Fundus photo, 45-degree field of view: 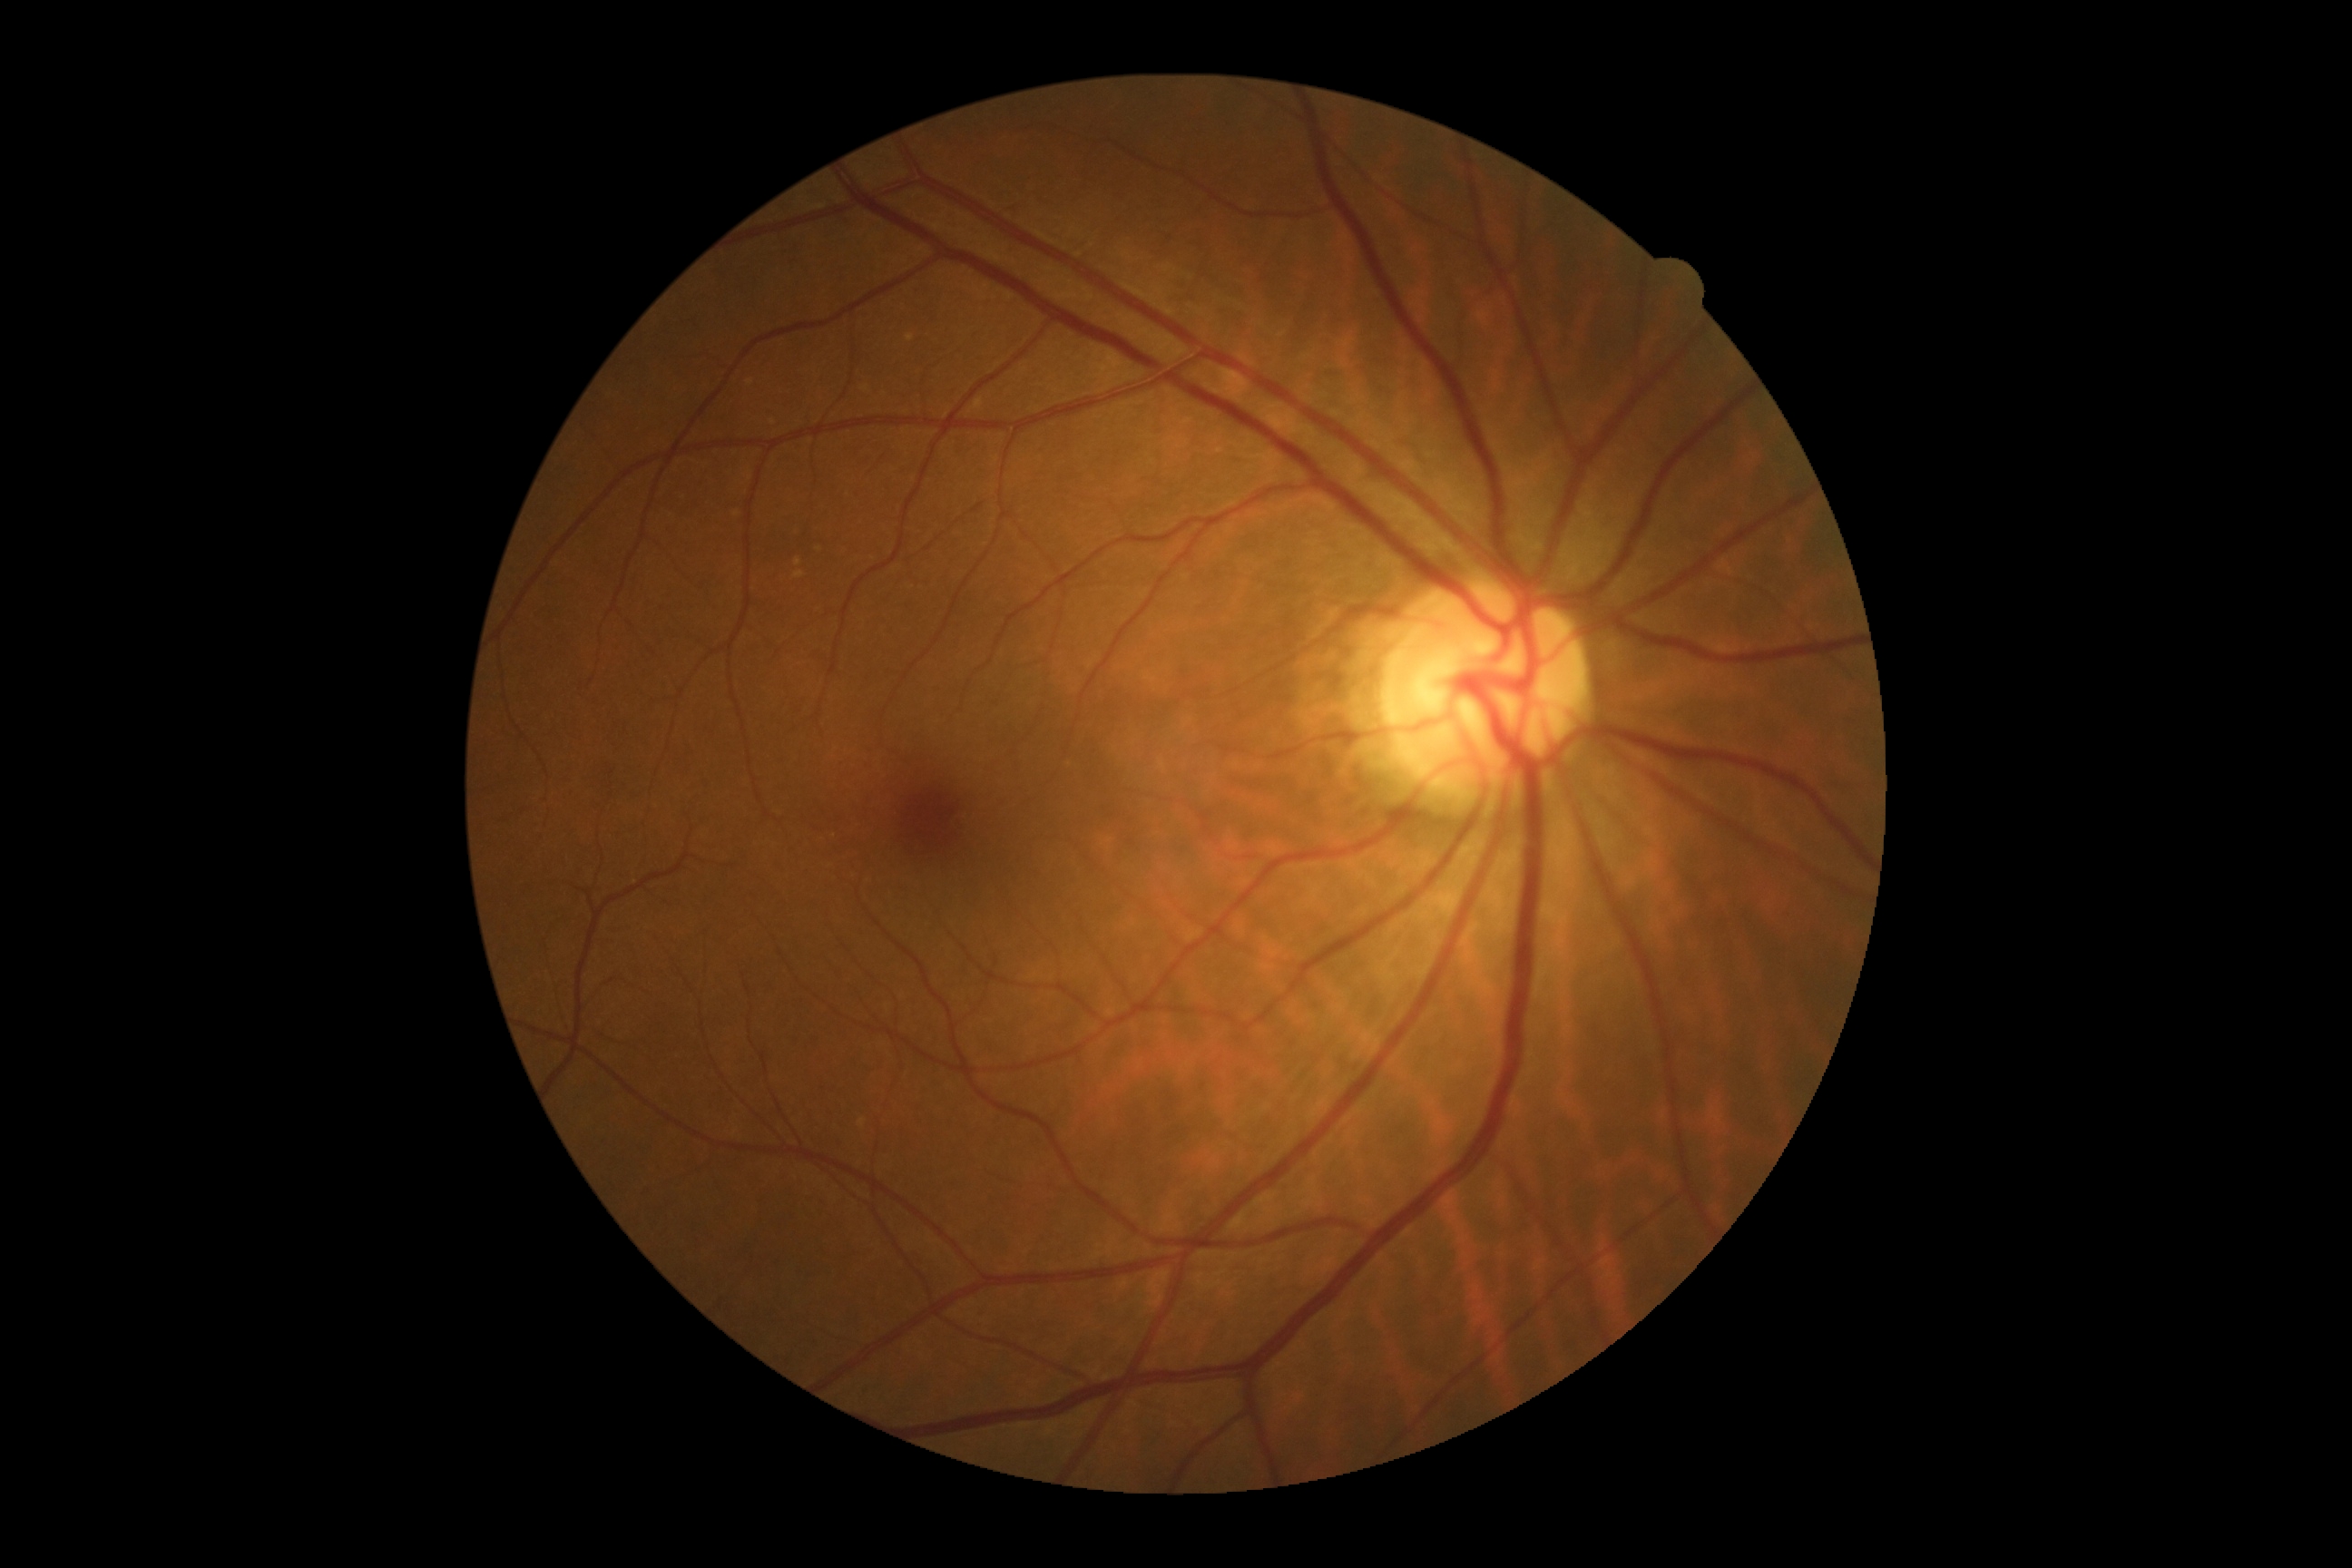 Findings:
– diabetic retinopathy severity: grade 0